No pharmacologic dilation.
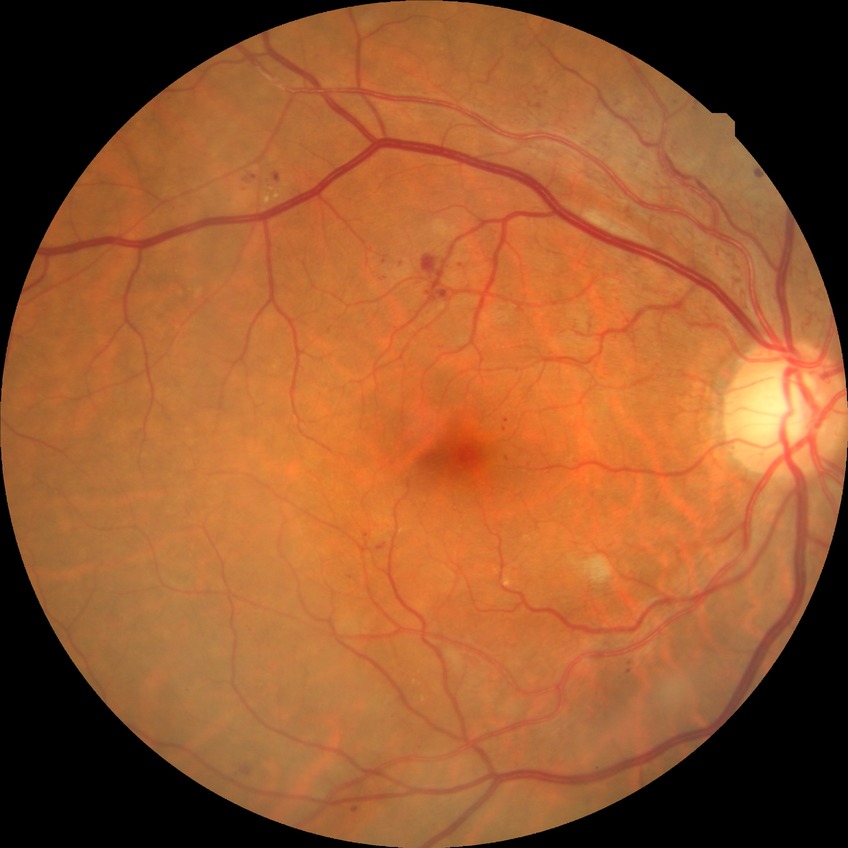 Diabetic retinopathy (DR) is PPDR (pre-proliferative diabetic retinopathy).